Pediatric wide-field fundus photograph — 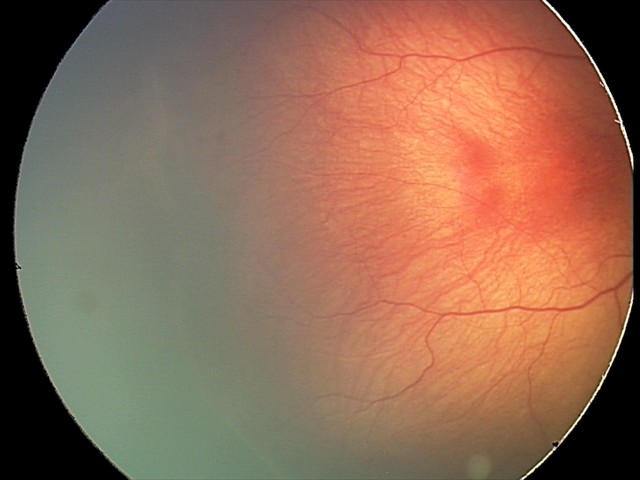 Plus disease absent.
Screening examination consistent with ROP stage 2.